CFP — 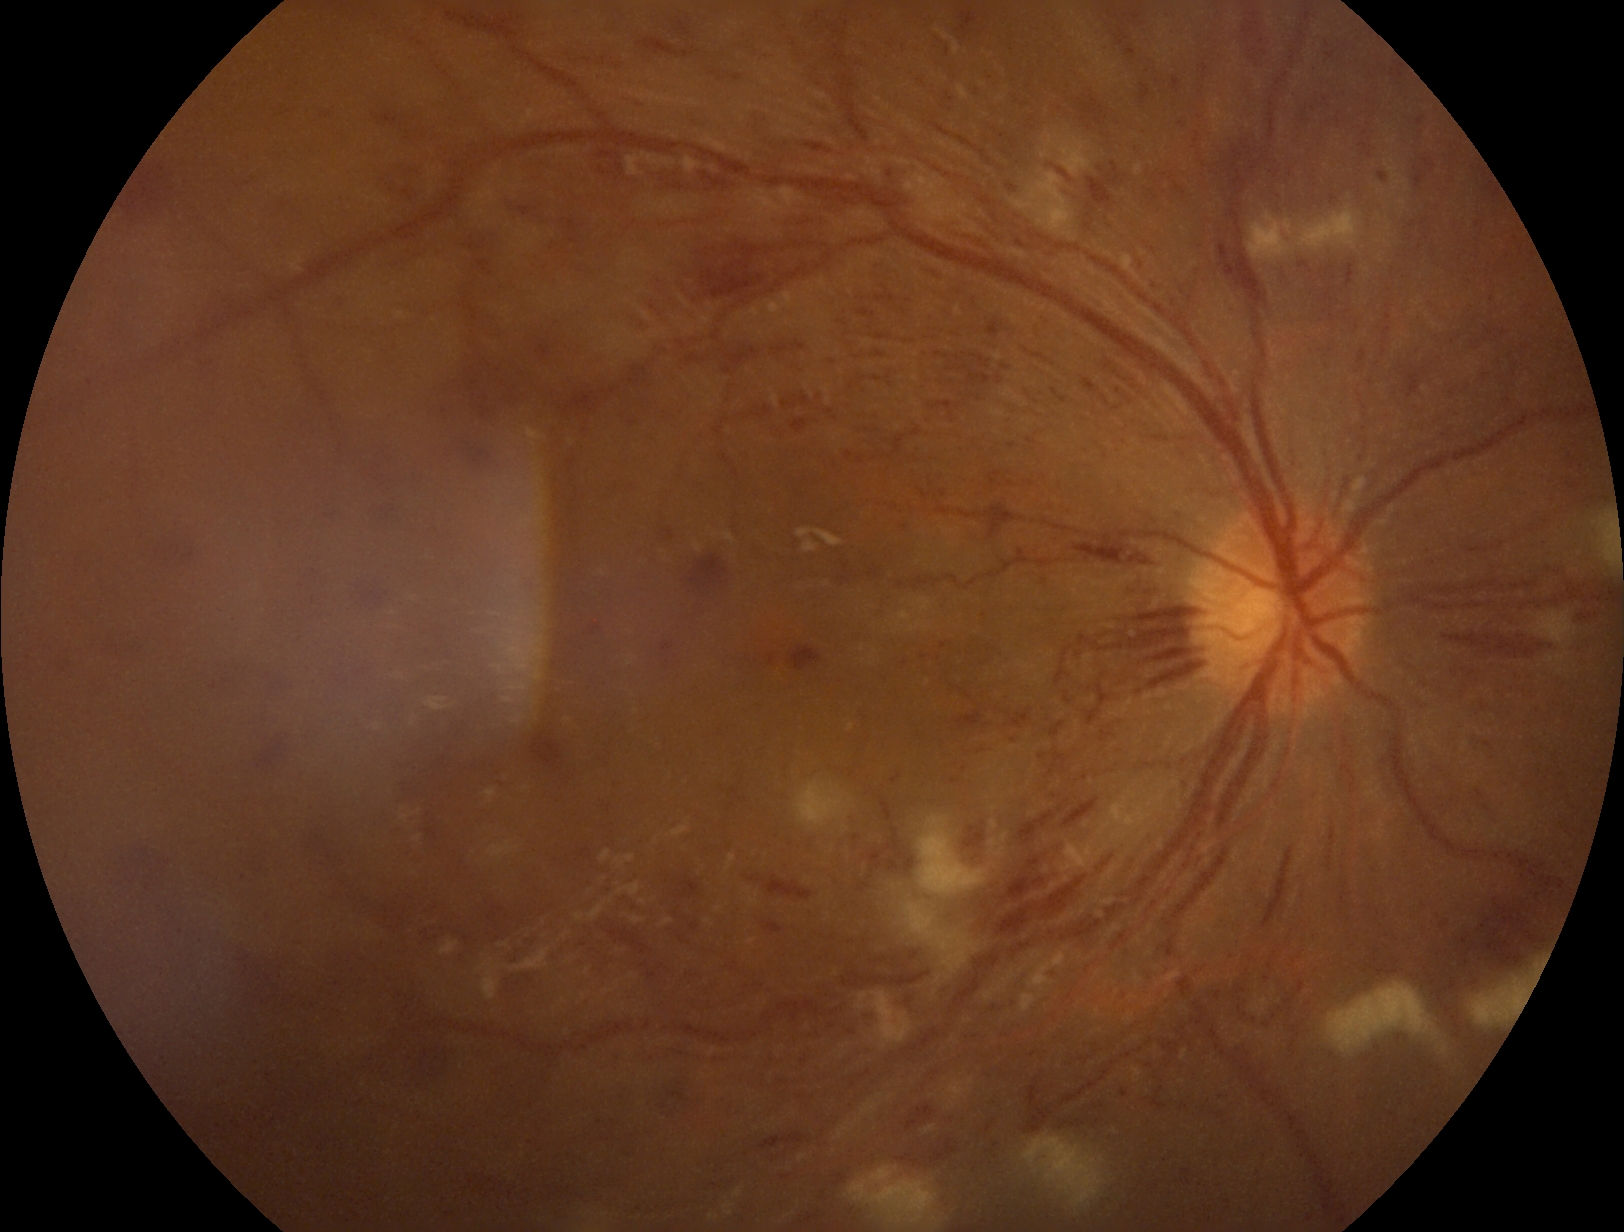
{"dr_grade": "3/4"}